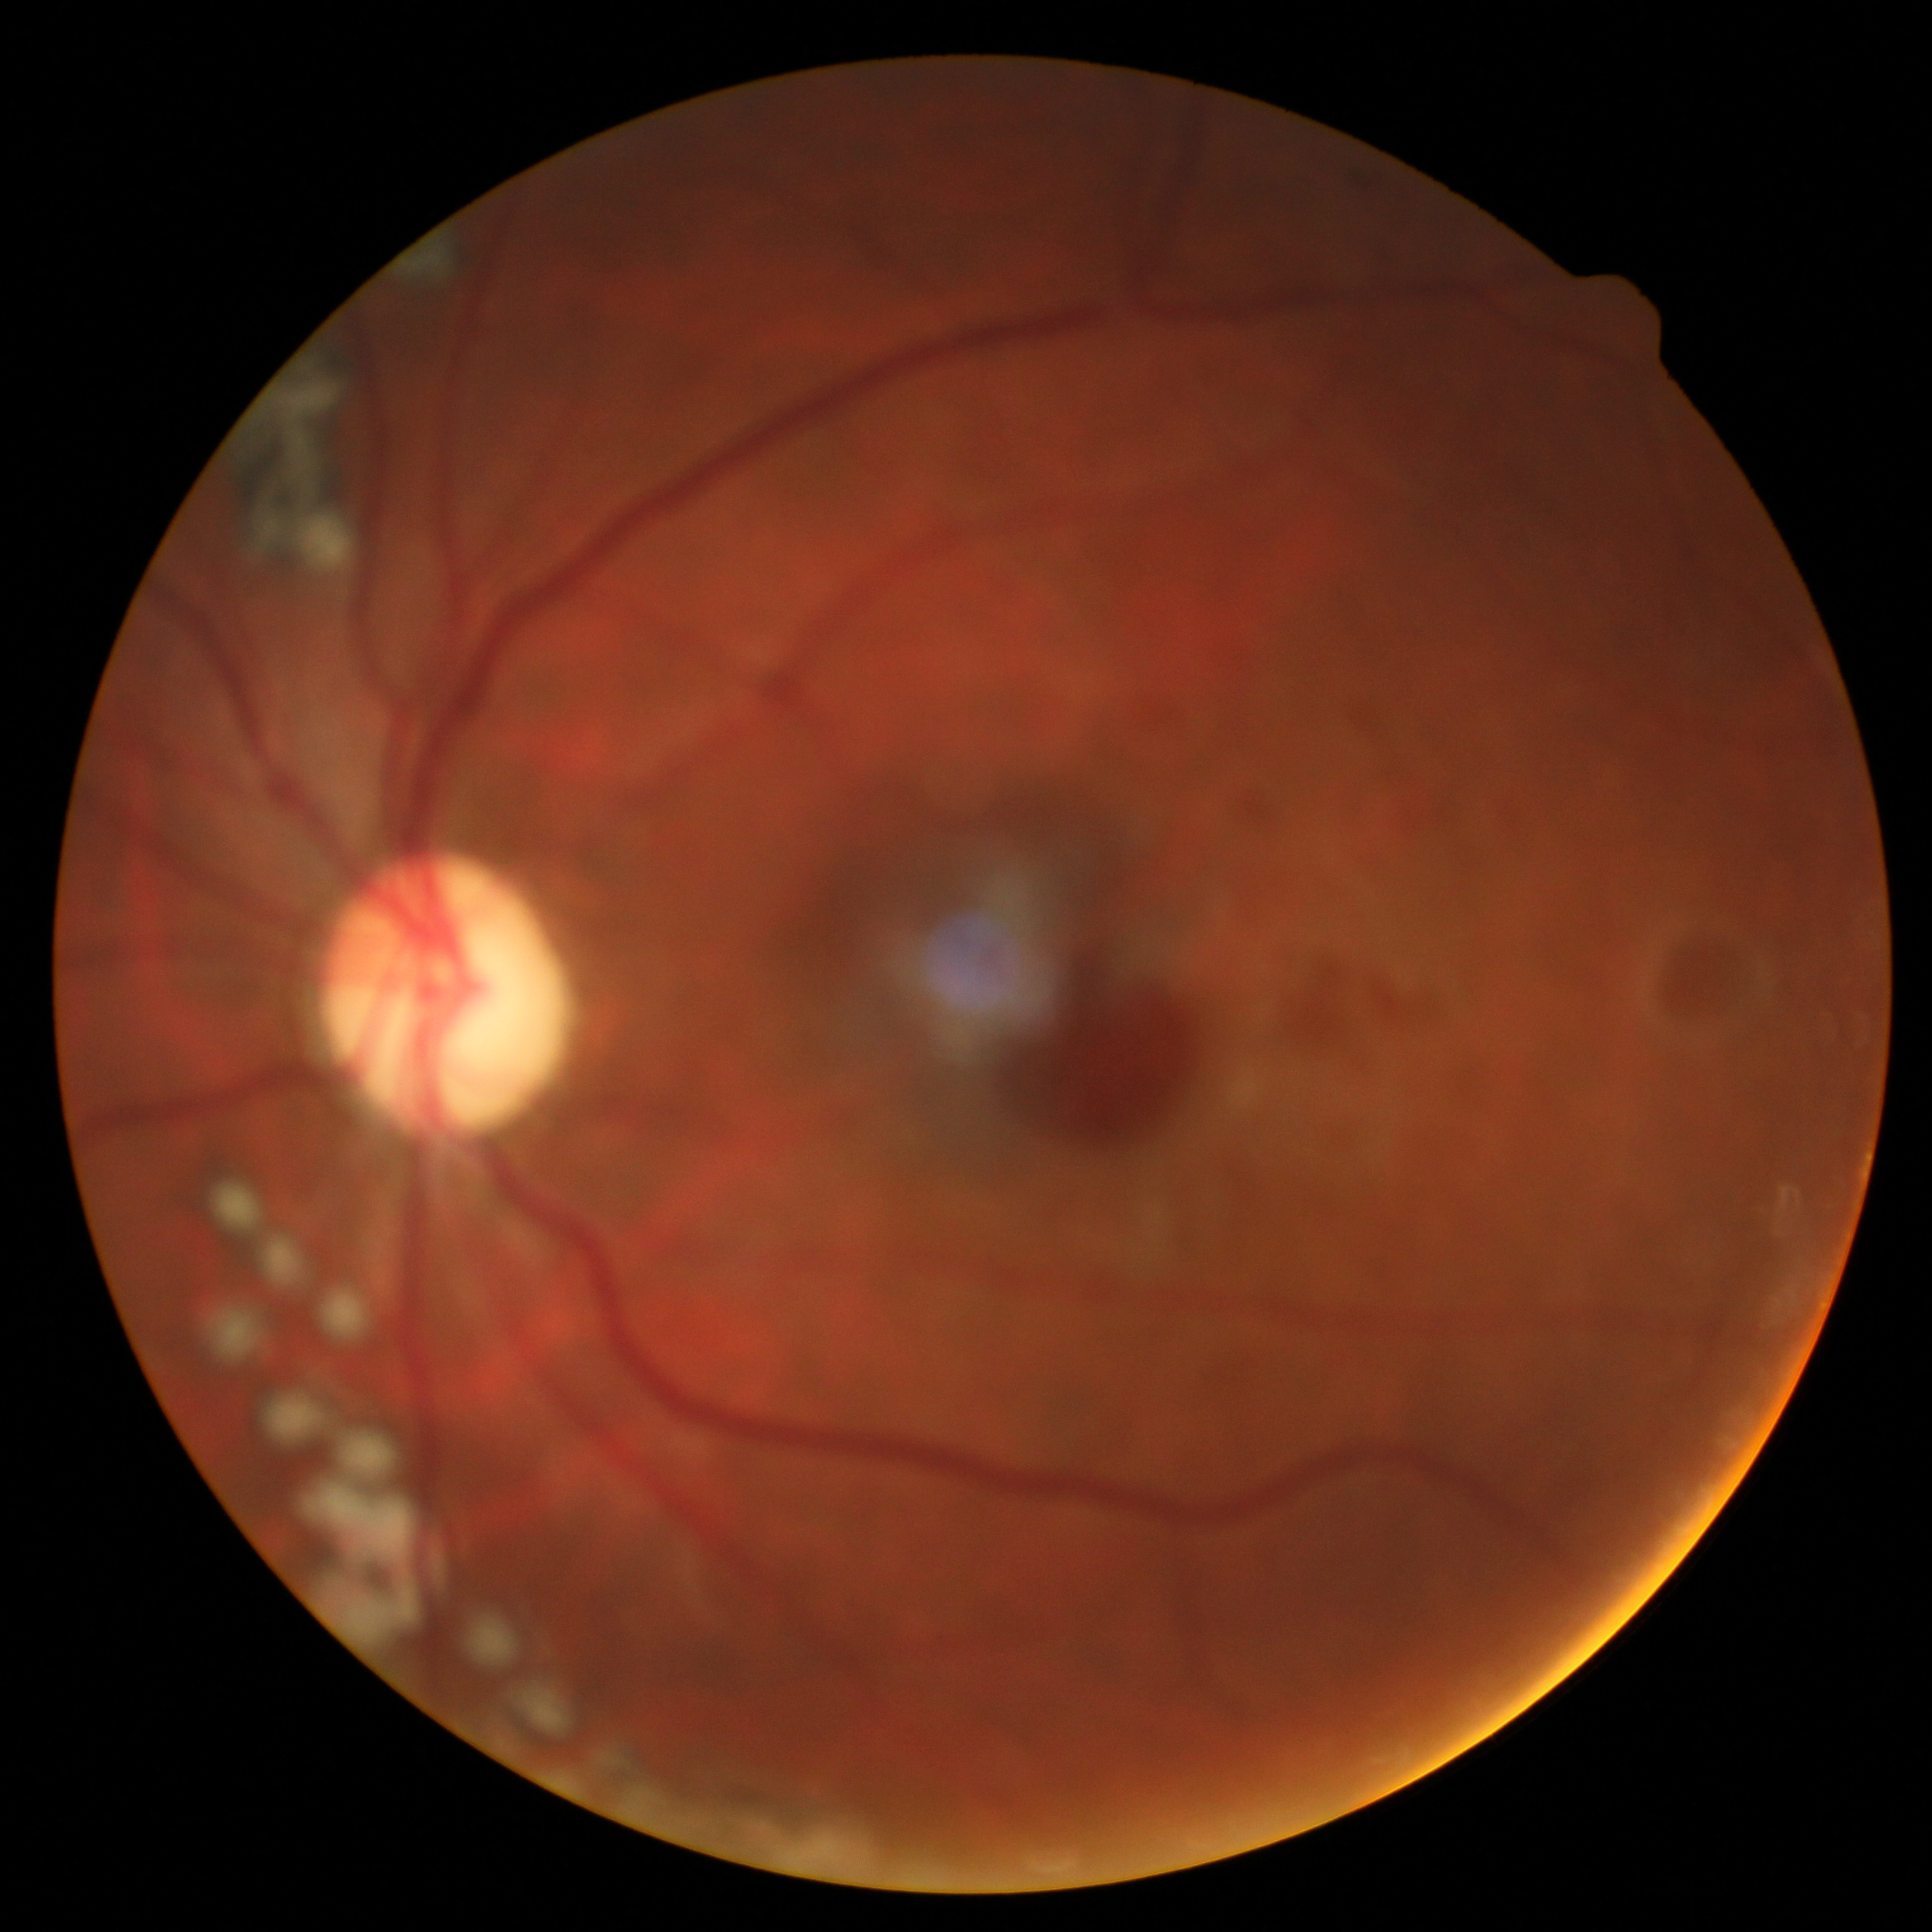 DR stage is grade 4 — neovascularization and/or vitreous/pre-retinal hemorrhage.